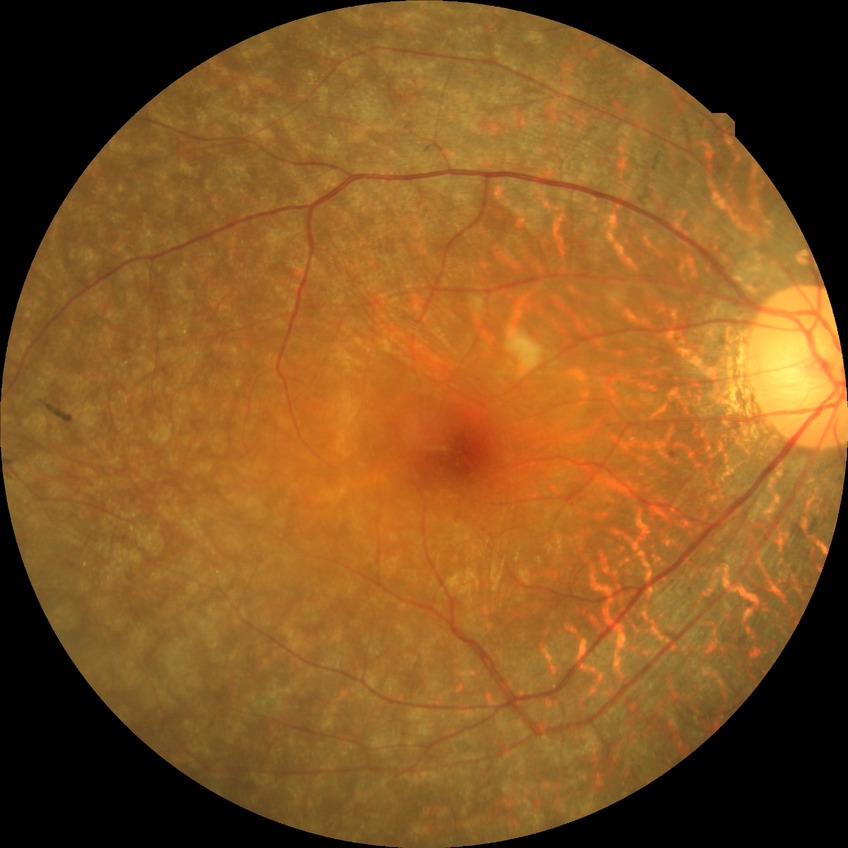
Diabetic retinopathy (DR) is no diabetic retinopathy (NDR).